45° field of view. 2352x1568px
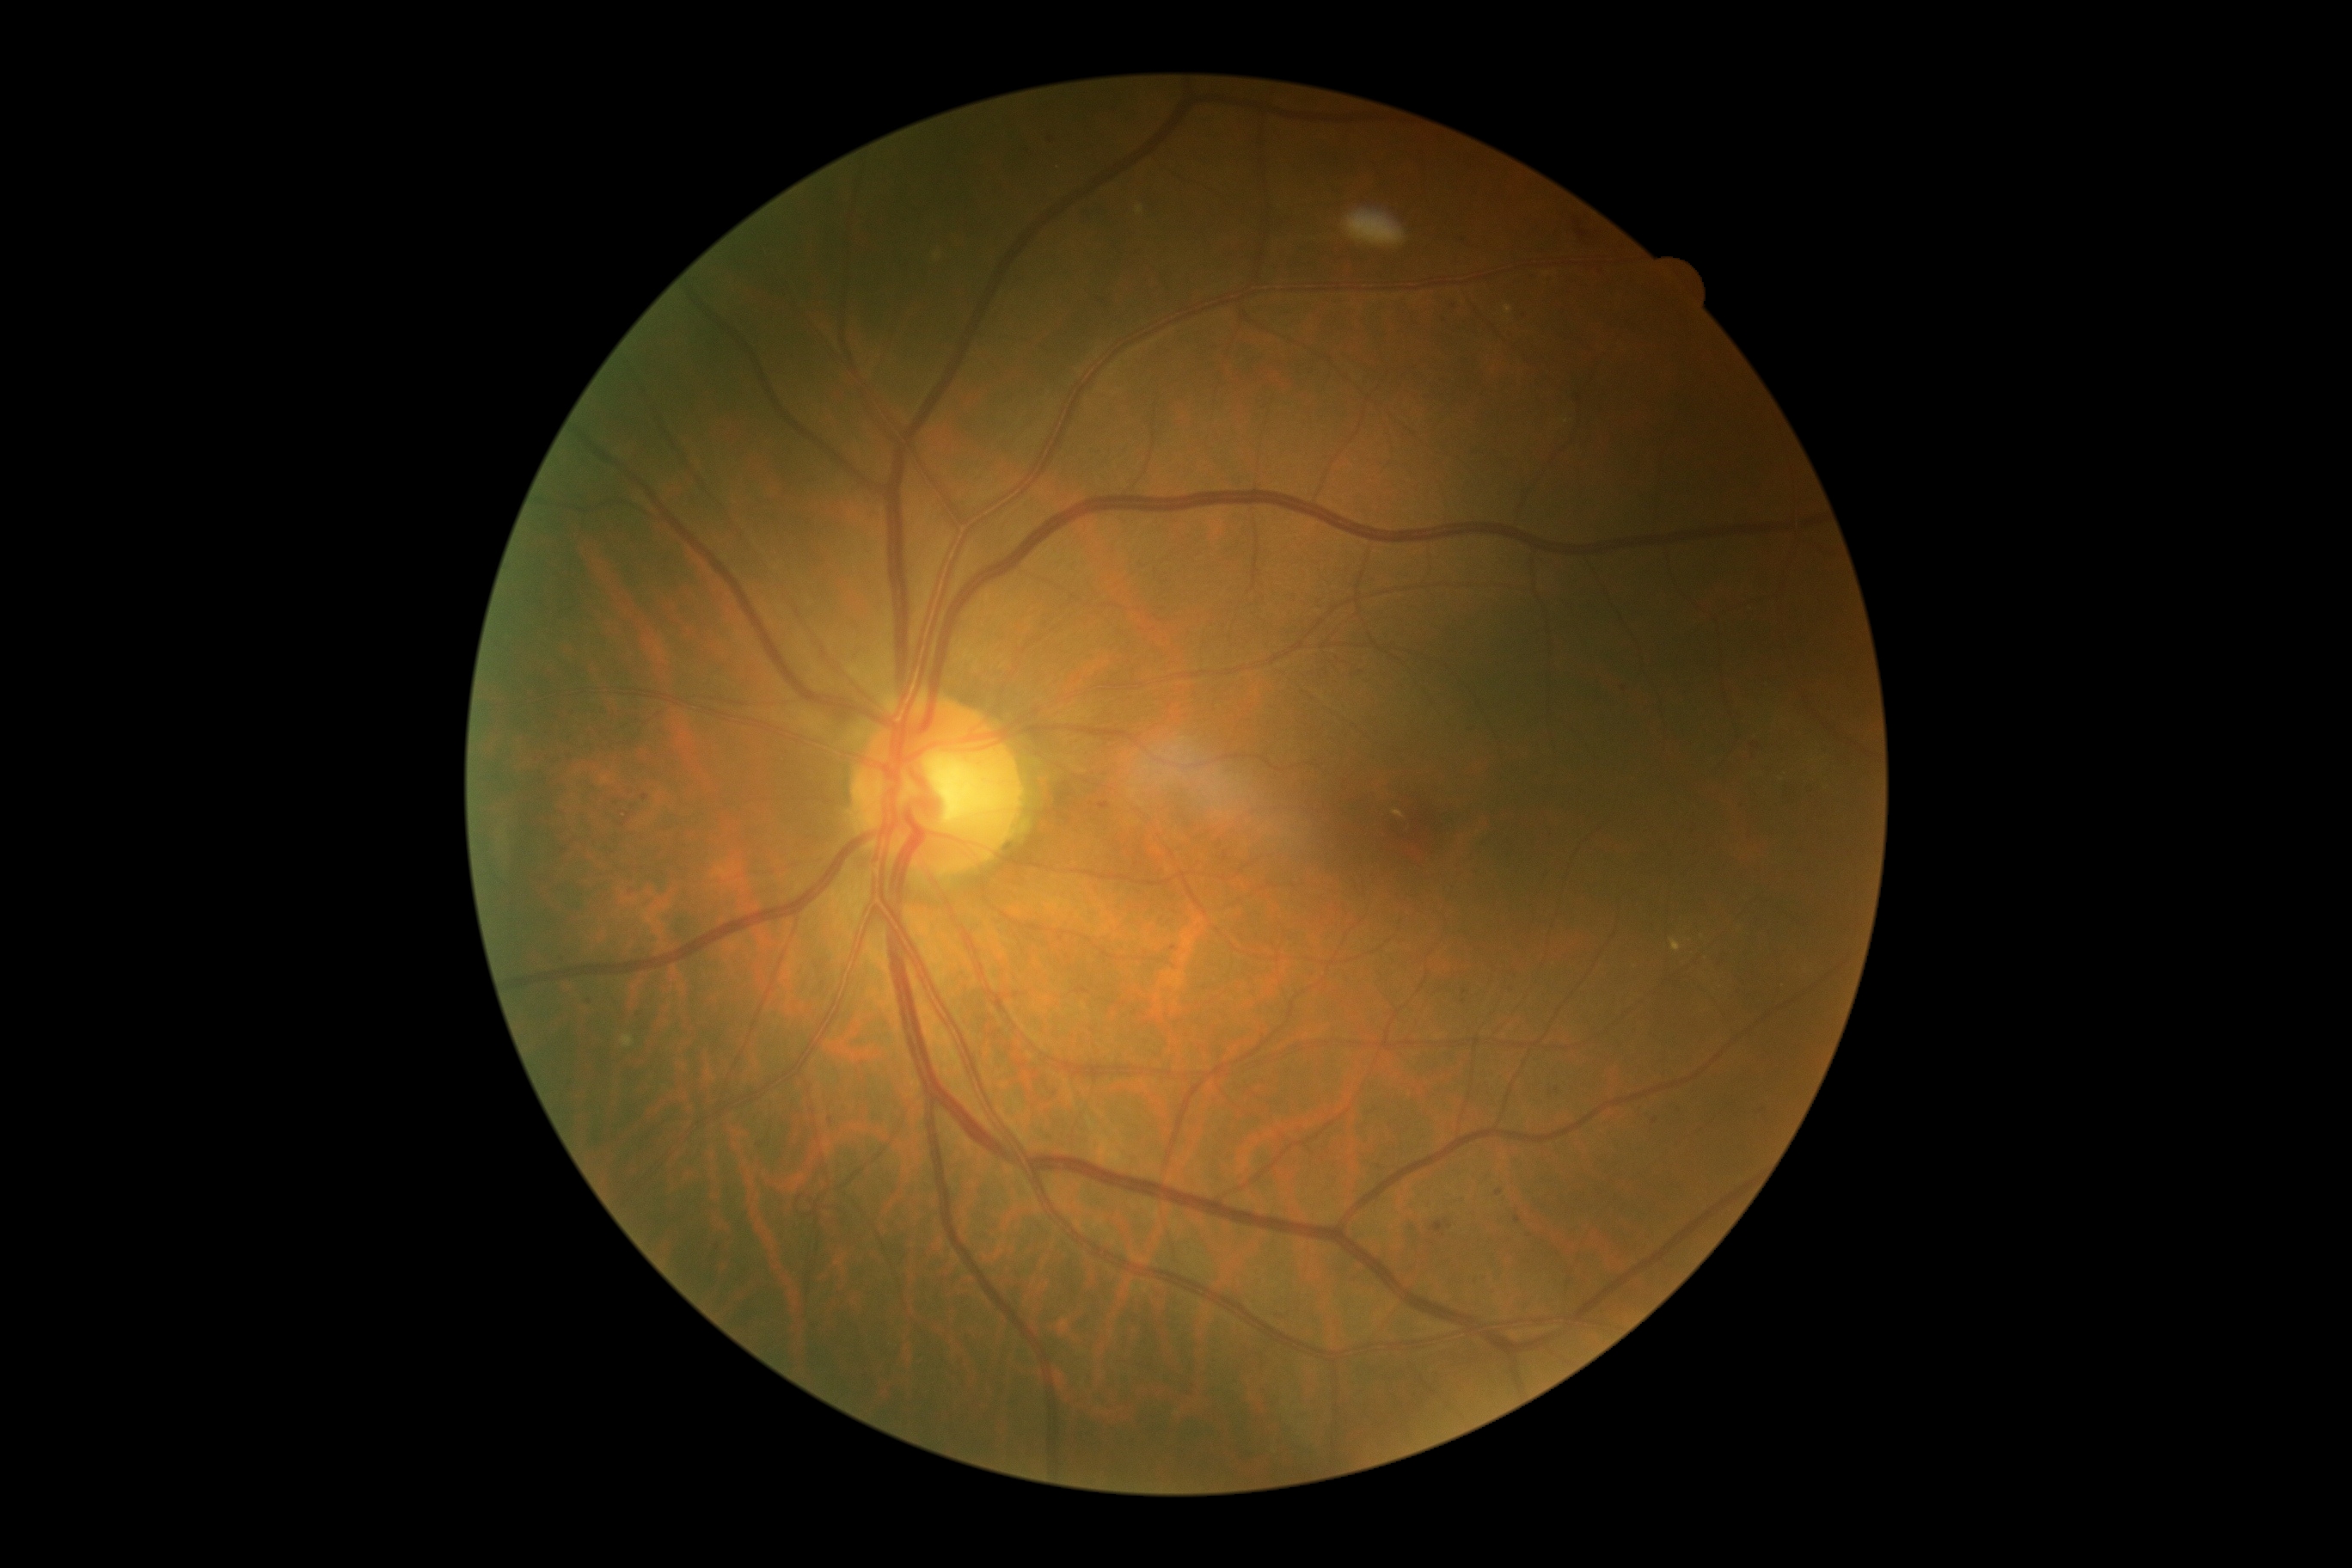

retinopathy=grade 2 (moderate NPDR).